Image size 240x240: 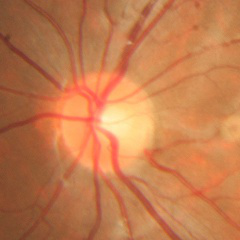 Glaucoma diagnosis = no signs of glaucoma.